2352 by 1568 pixels. Color fundus image.
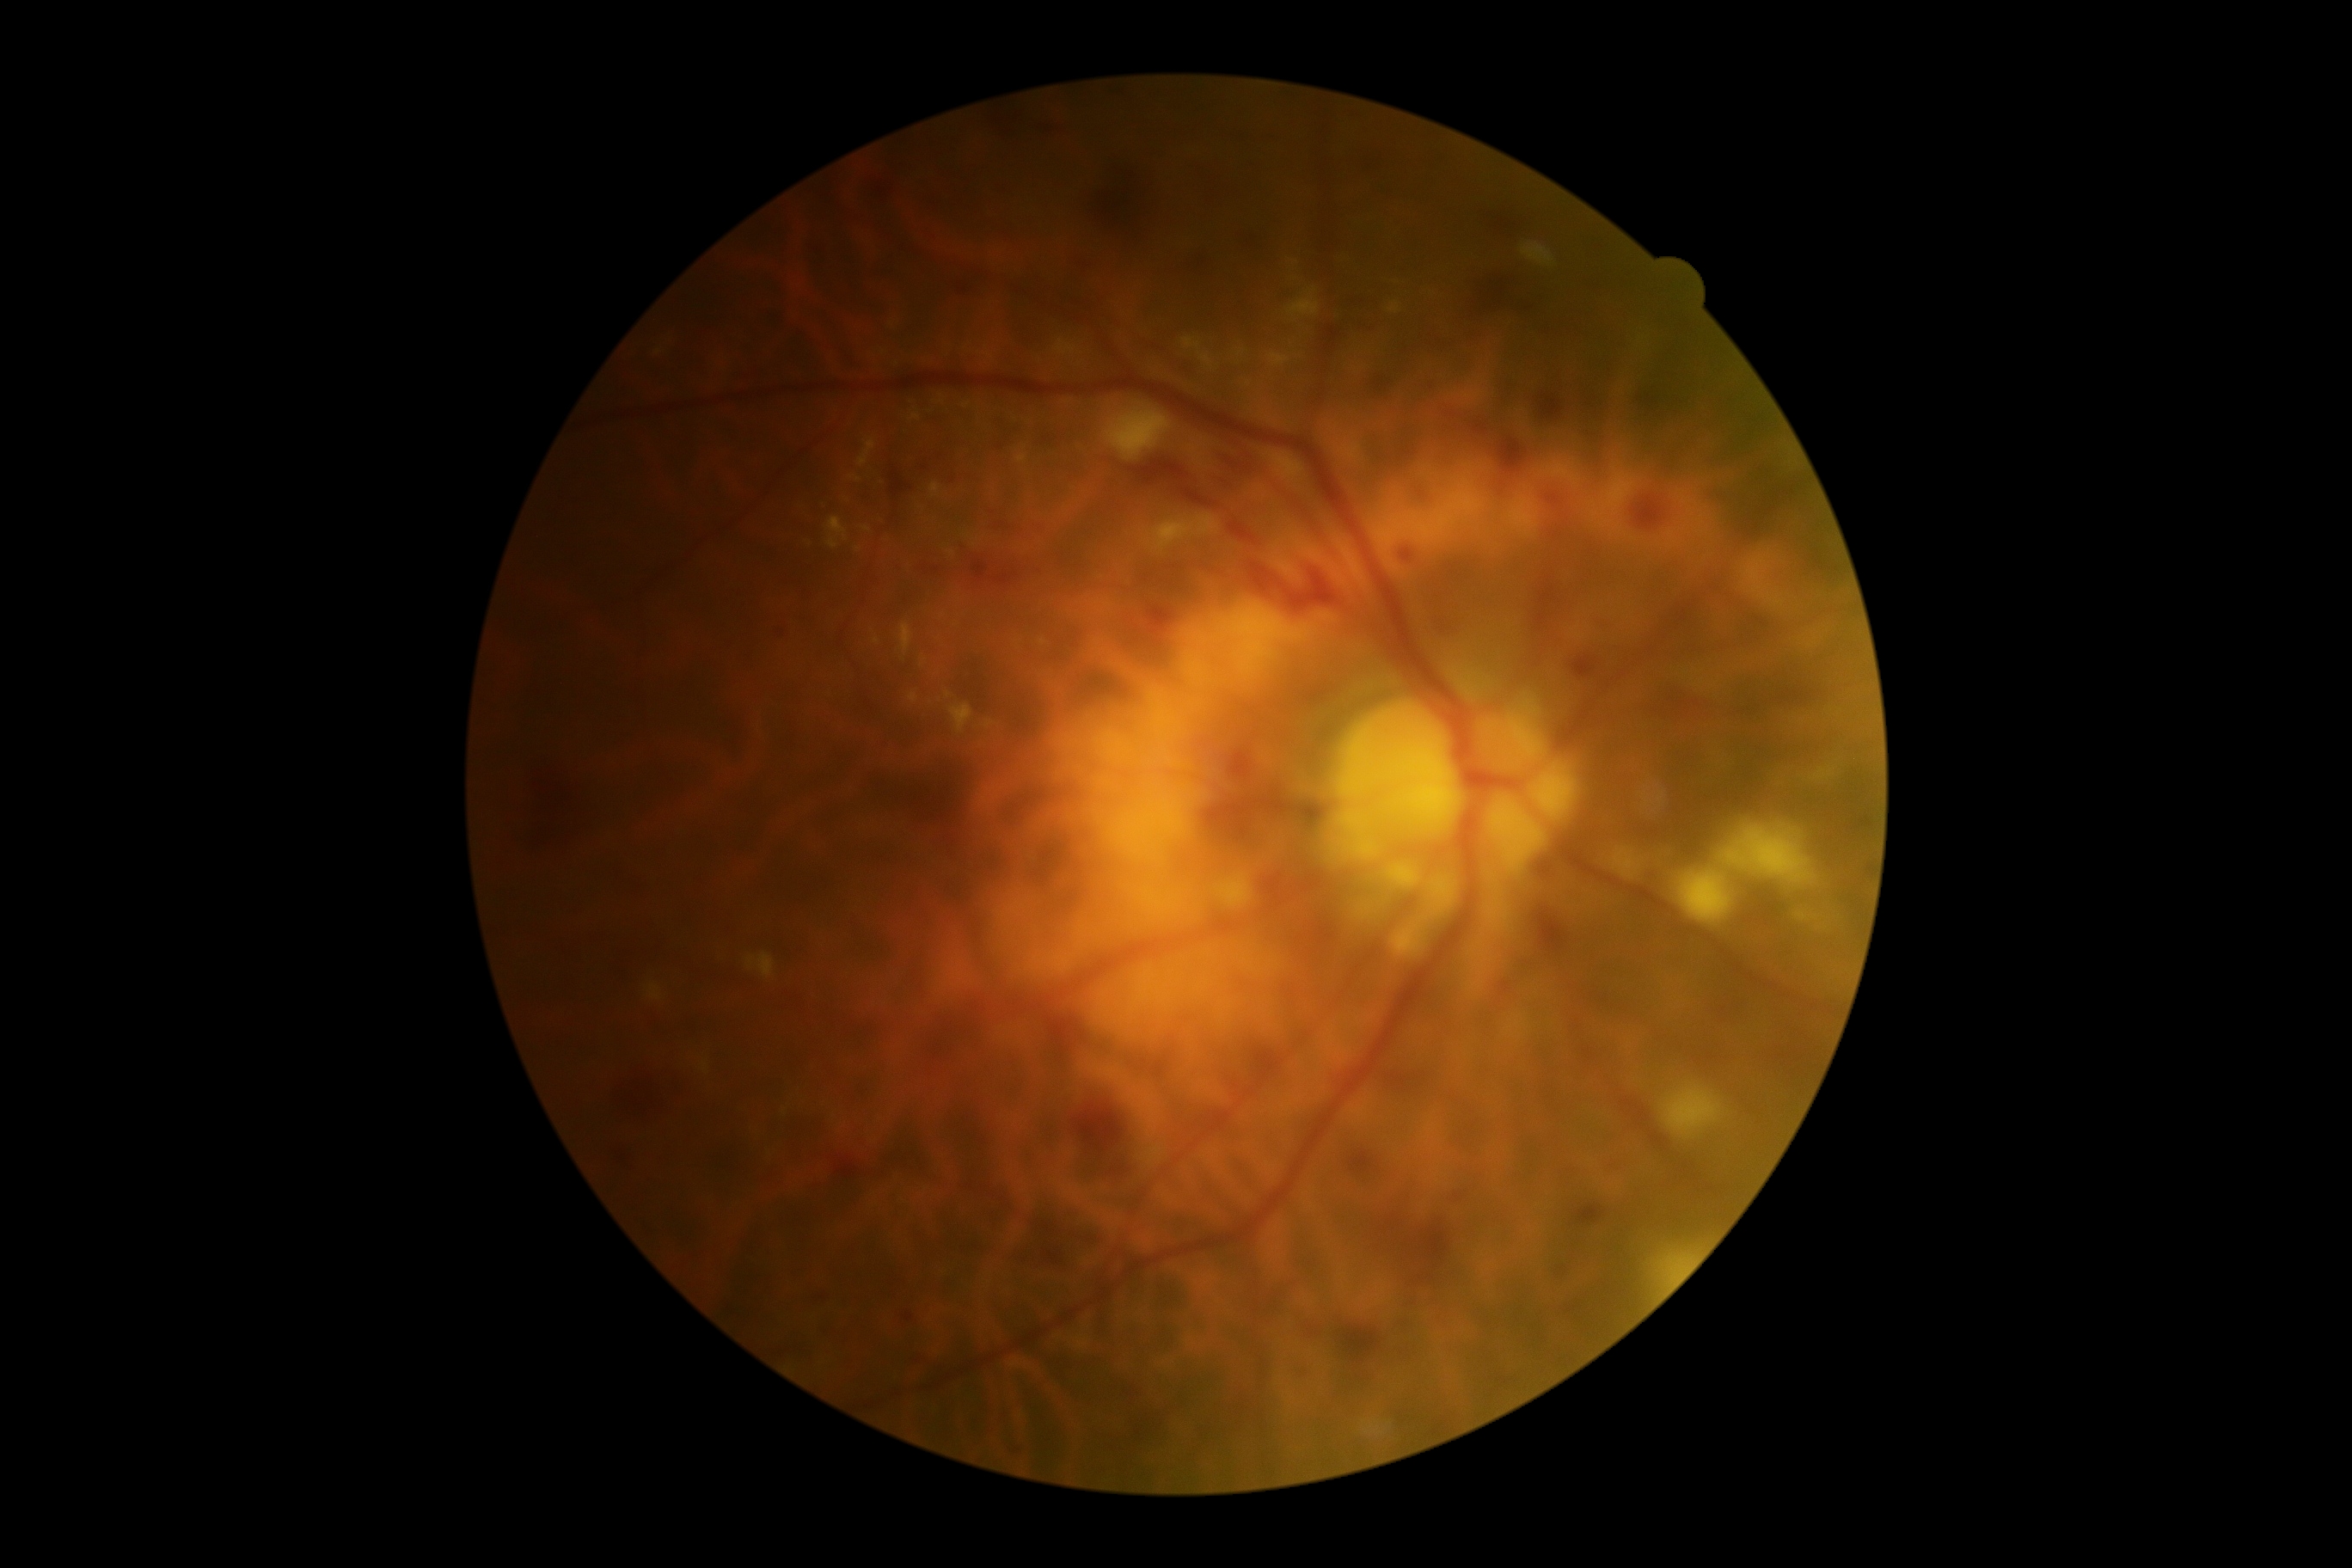
DR severity is 2/4.